Image size 2212x1659: 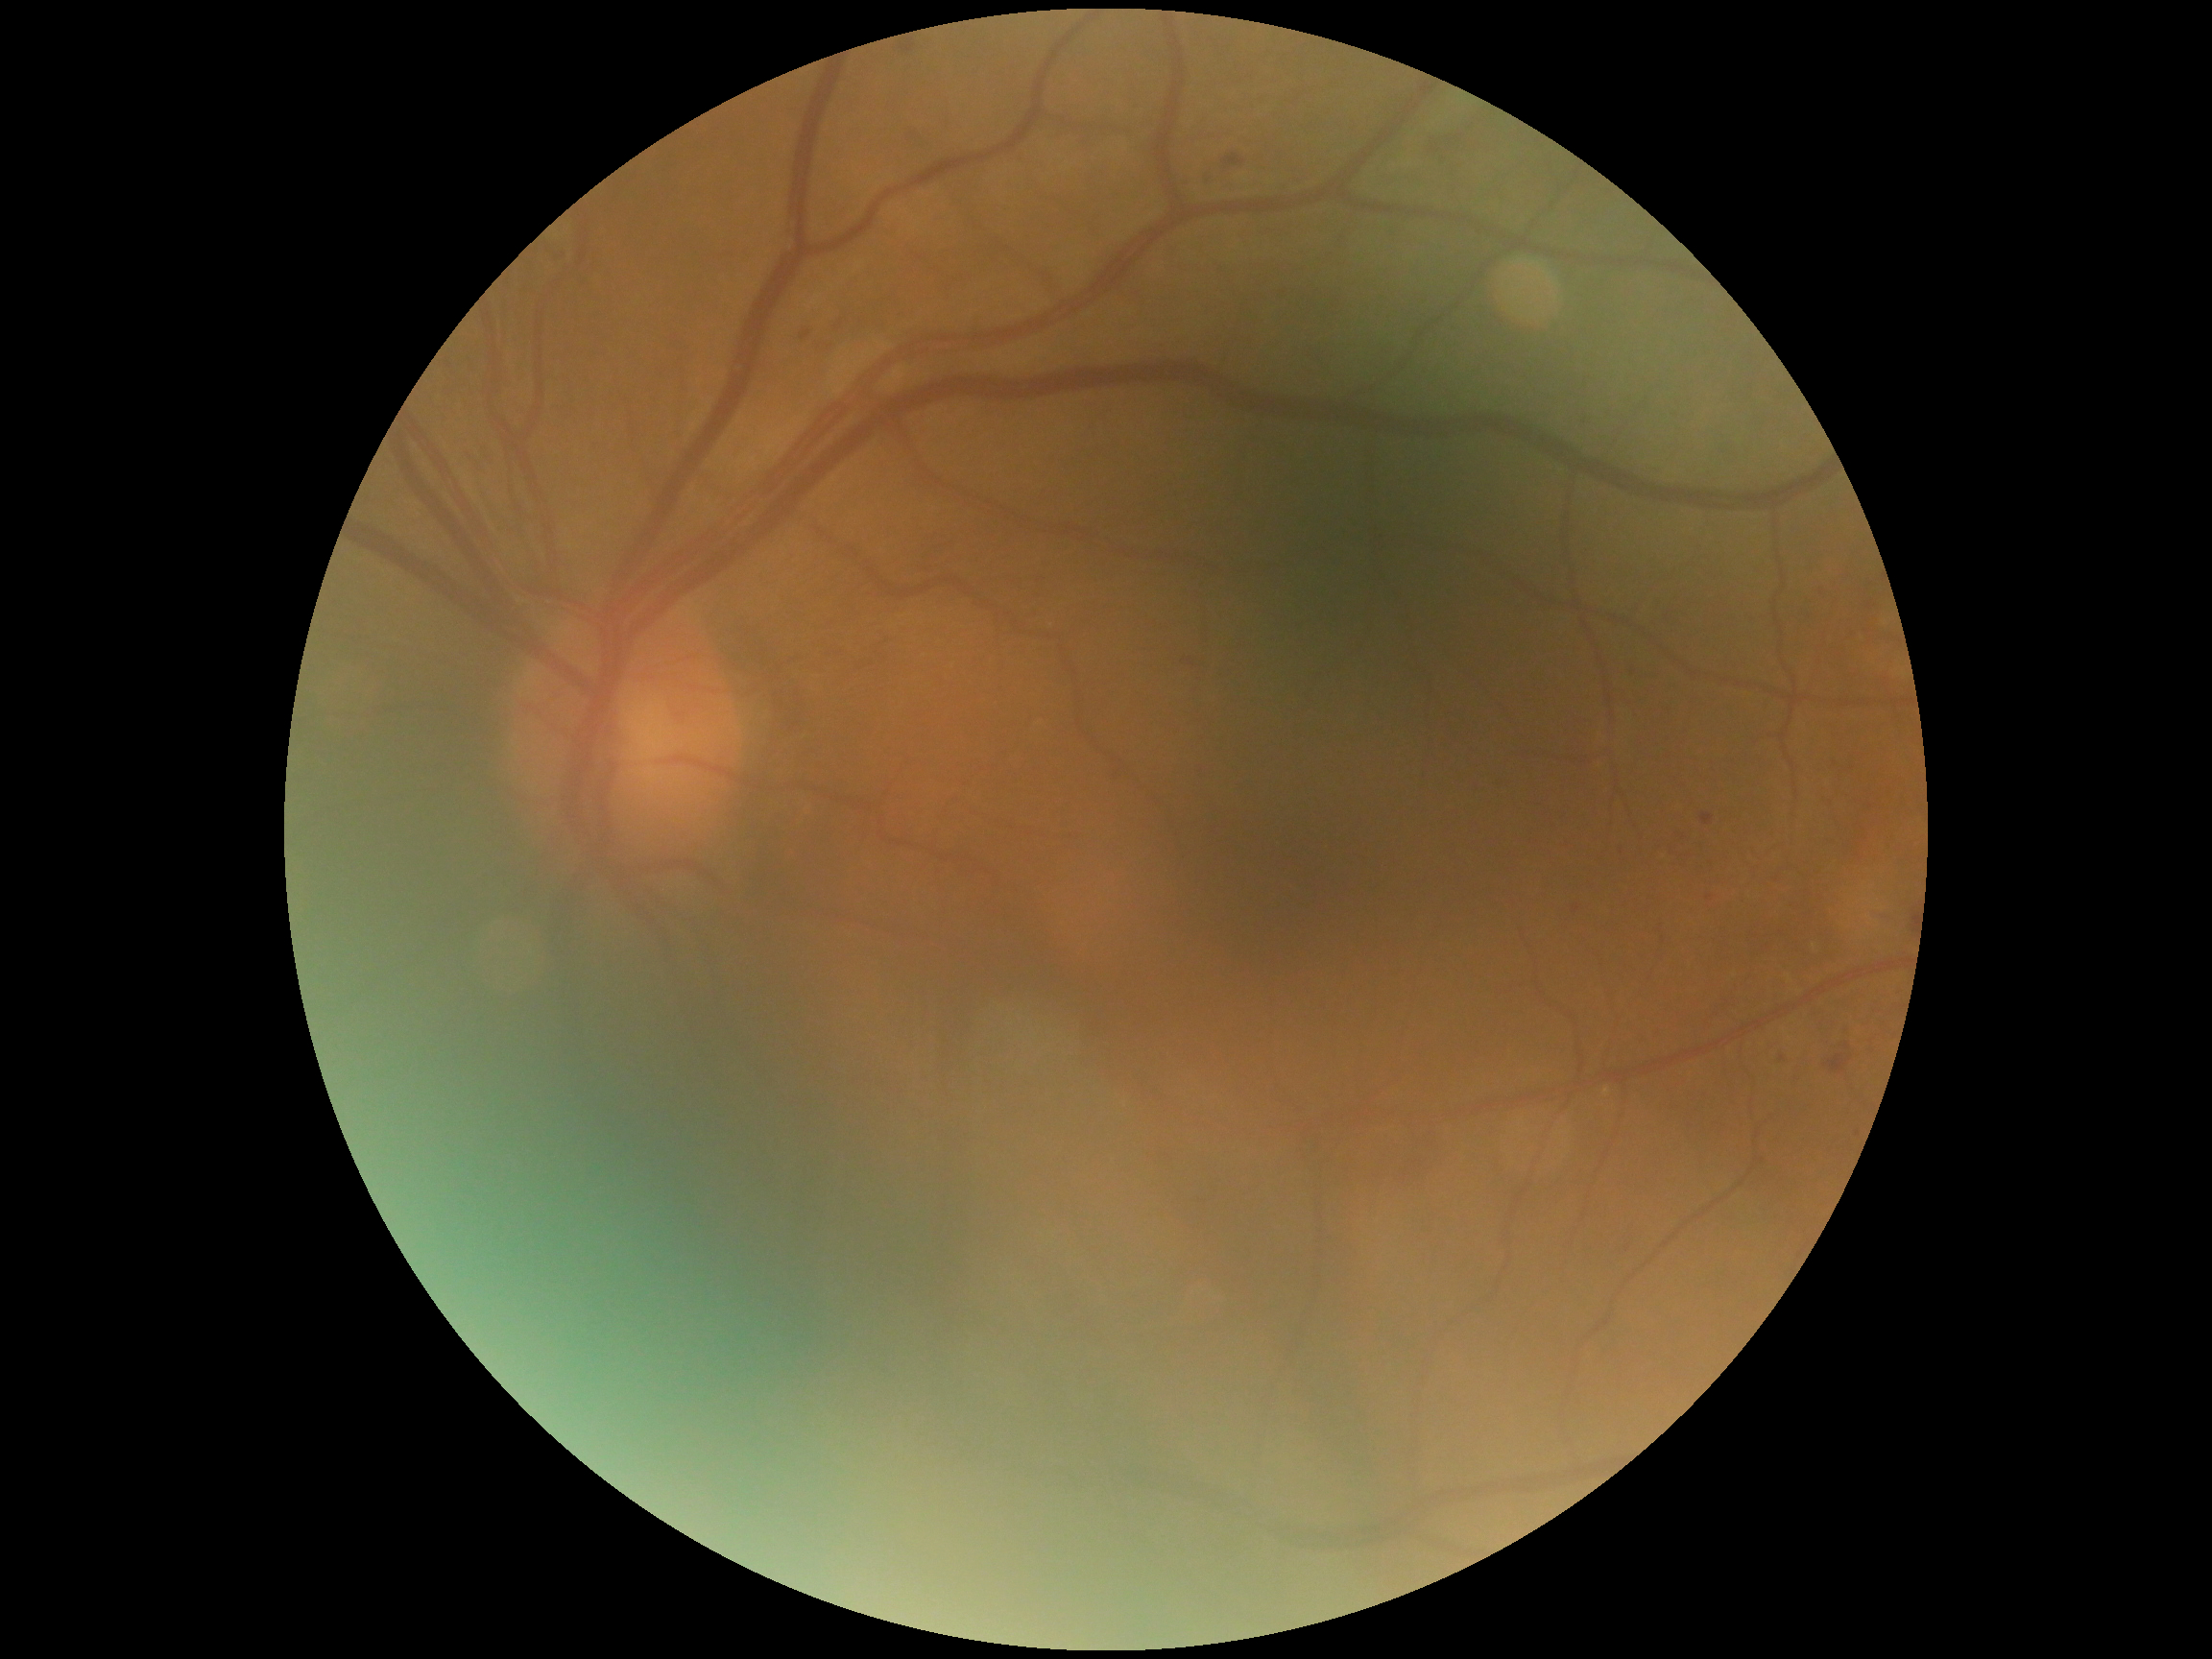
{
  "dr_grade": "2/4"
}